Fundus photo
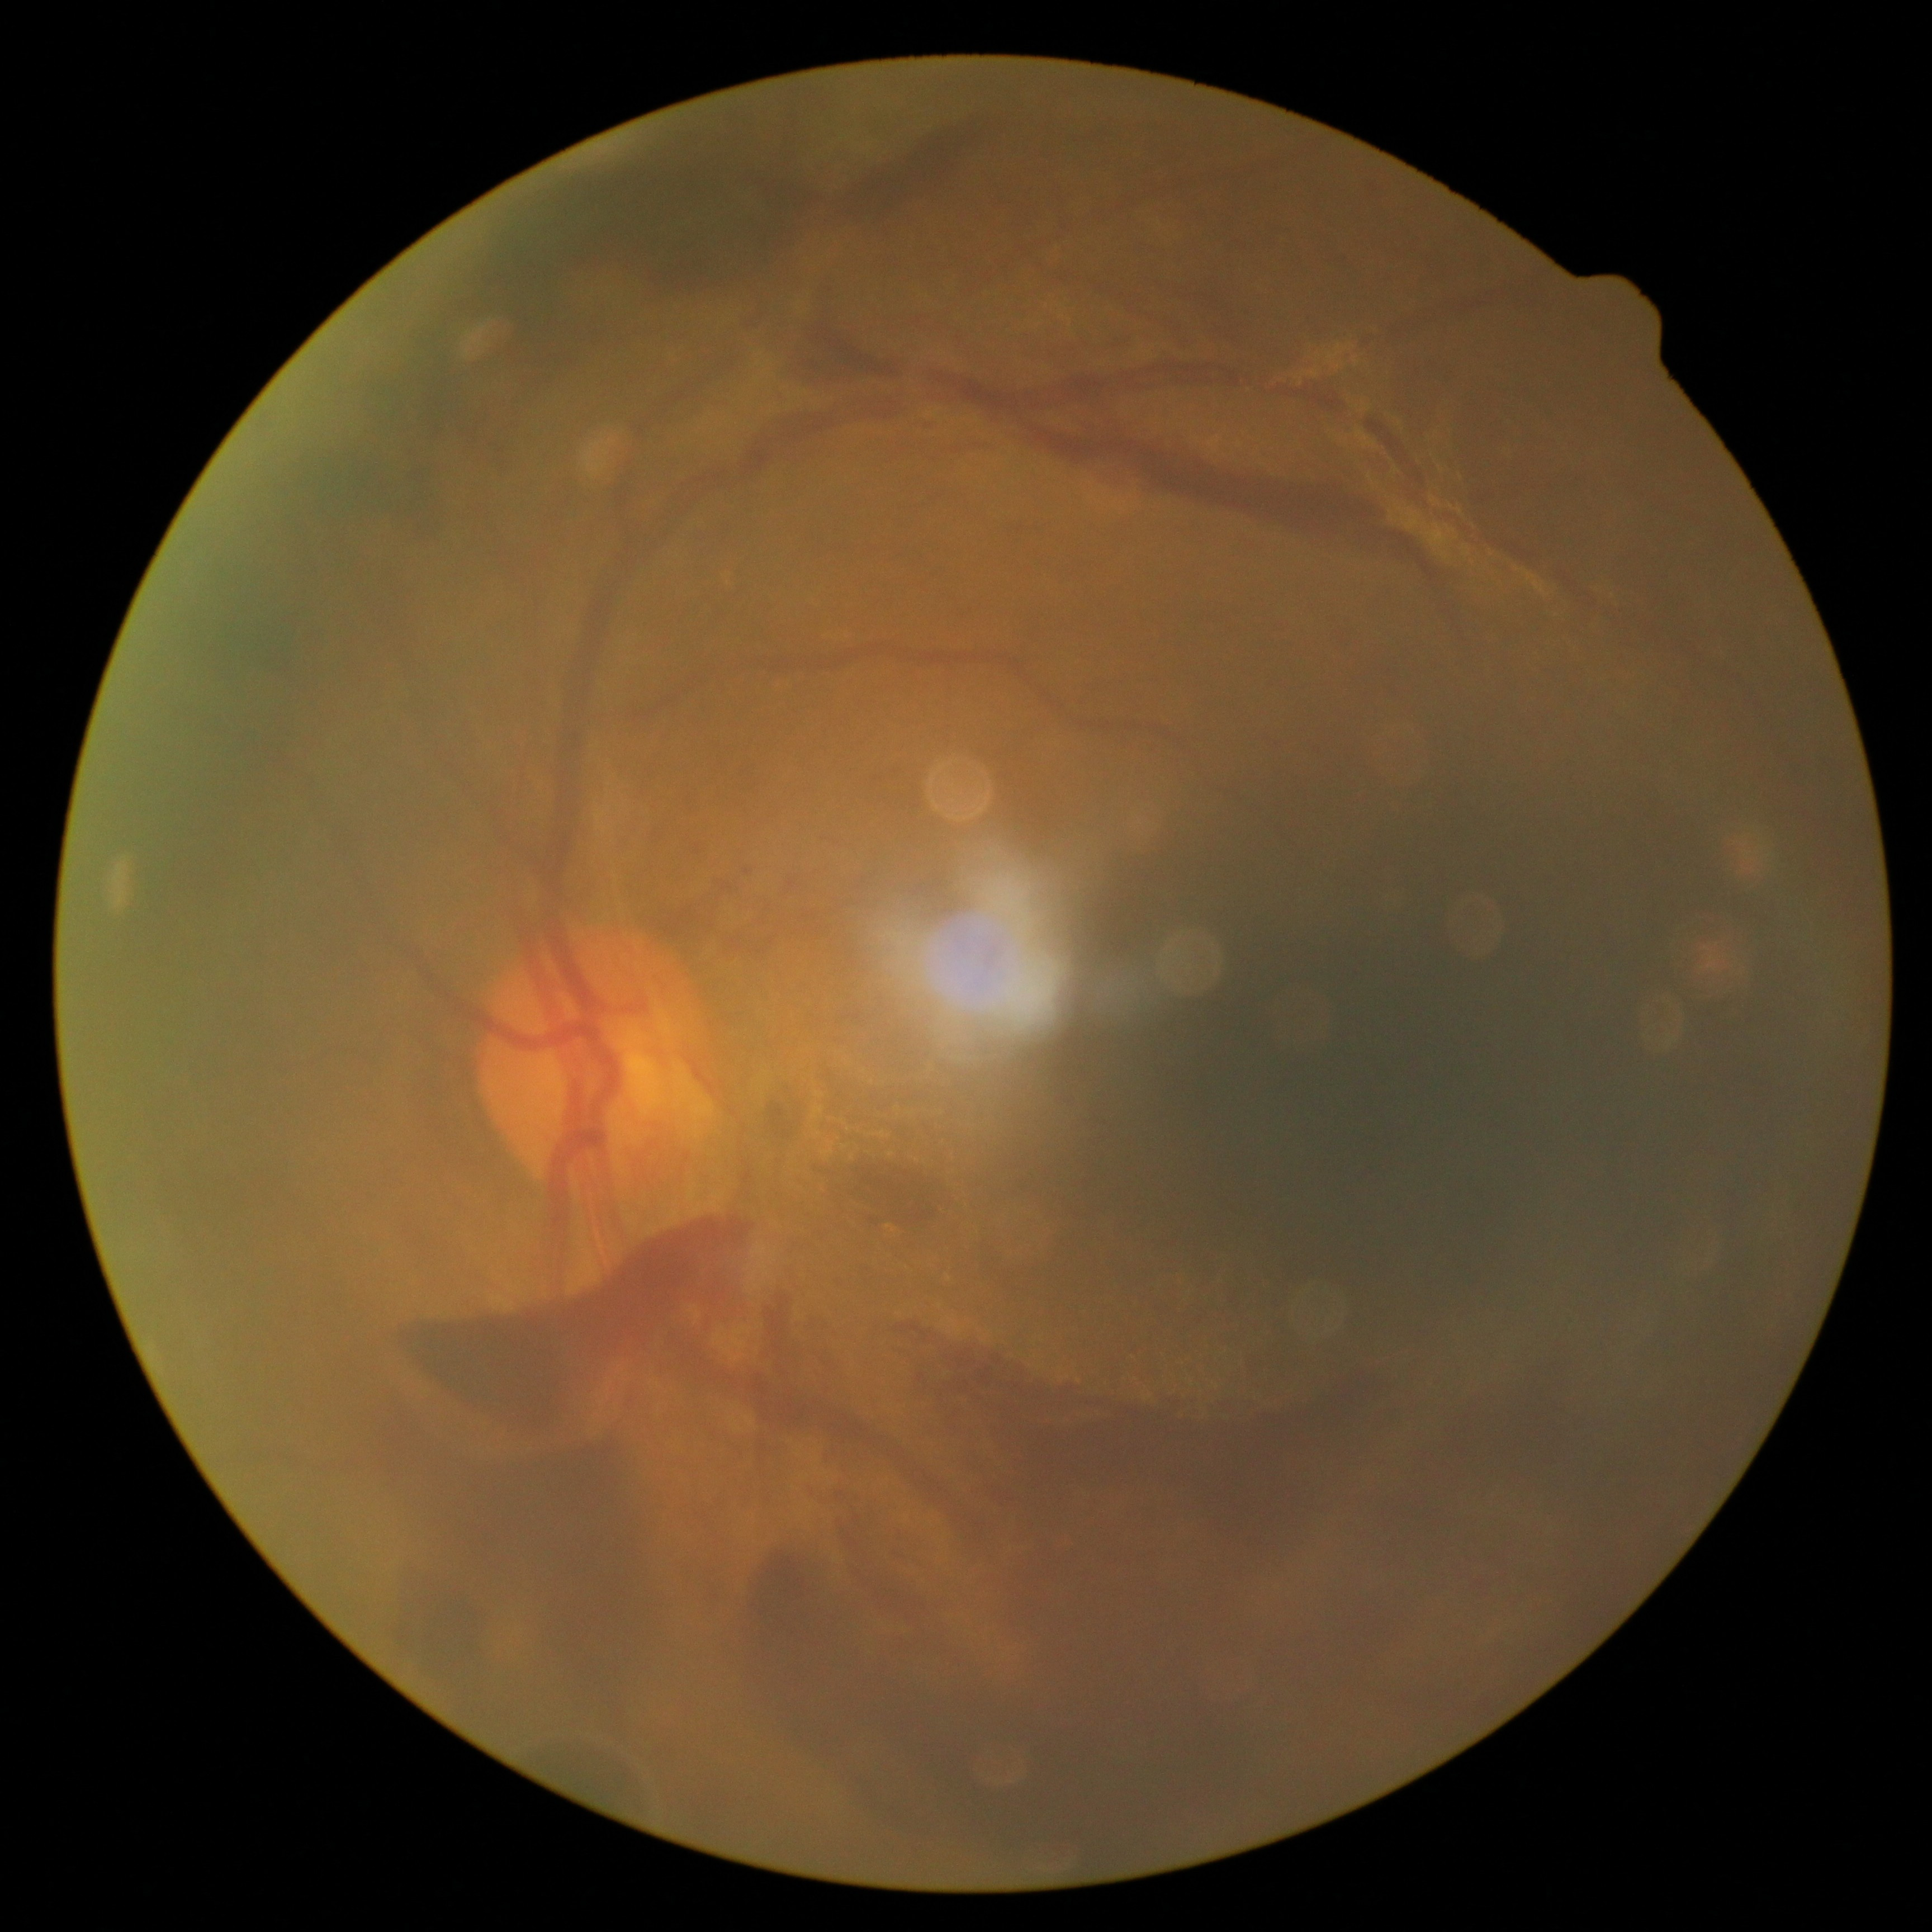

Findings:
- diabetic retinopathy severity: 4